FOV: 50 degrees · dilated-pupil acquisition · 2228 by 1652 pixels · color fundus image · captured on a Topcon TRC-50DX fundus camera: 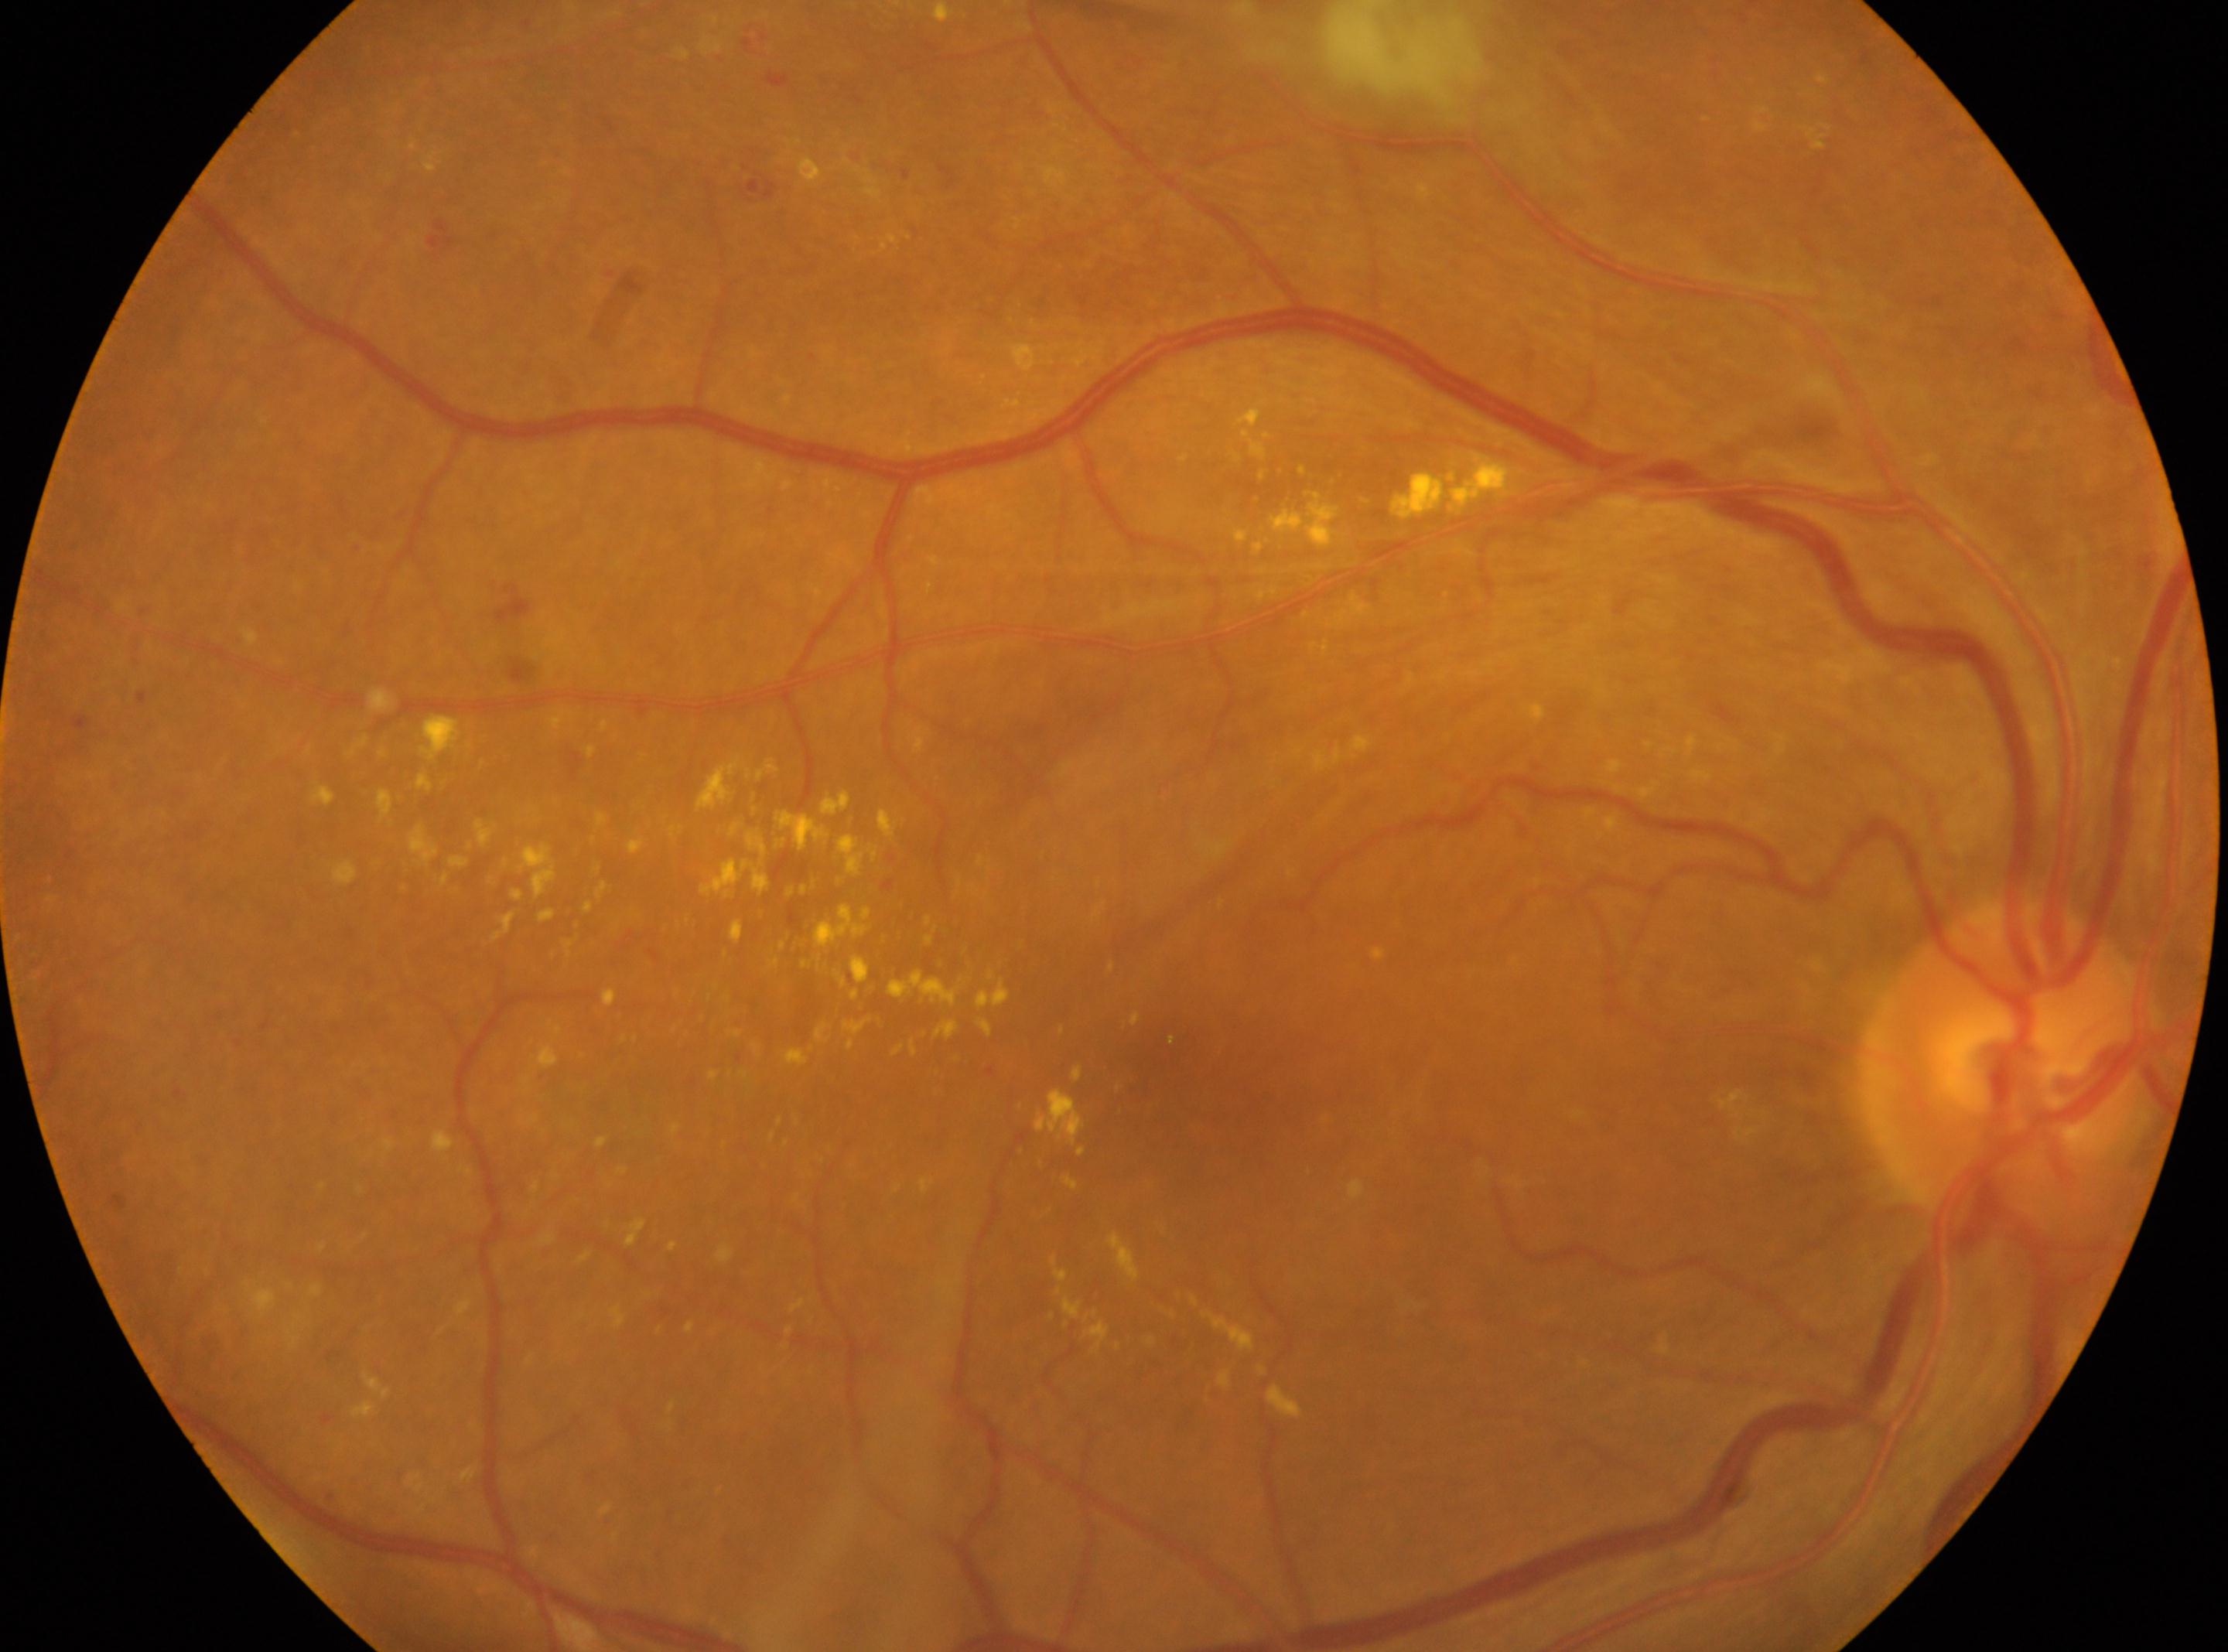
Annotations:
– optic disc center: 2004px, 1057px
– the fovea: 1187px, 1080px
– DR severity: 4/4
– laterality: right eye